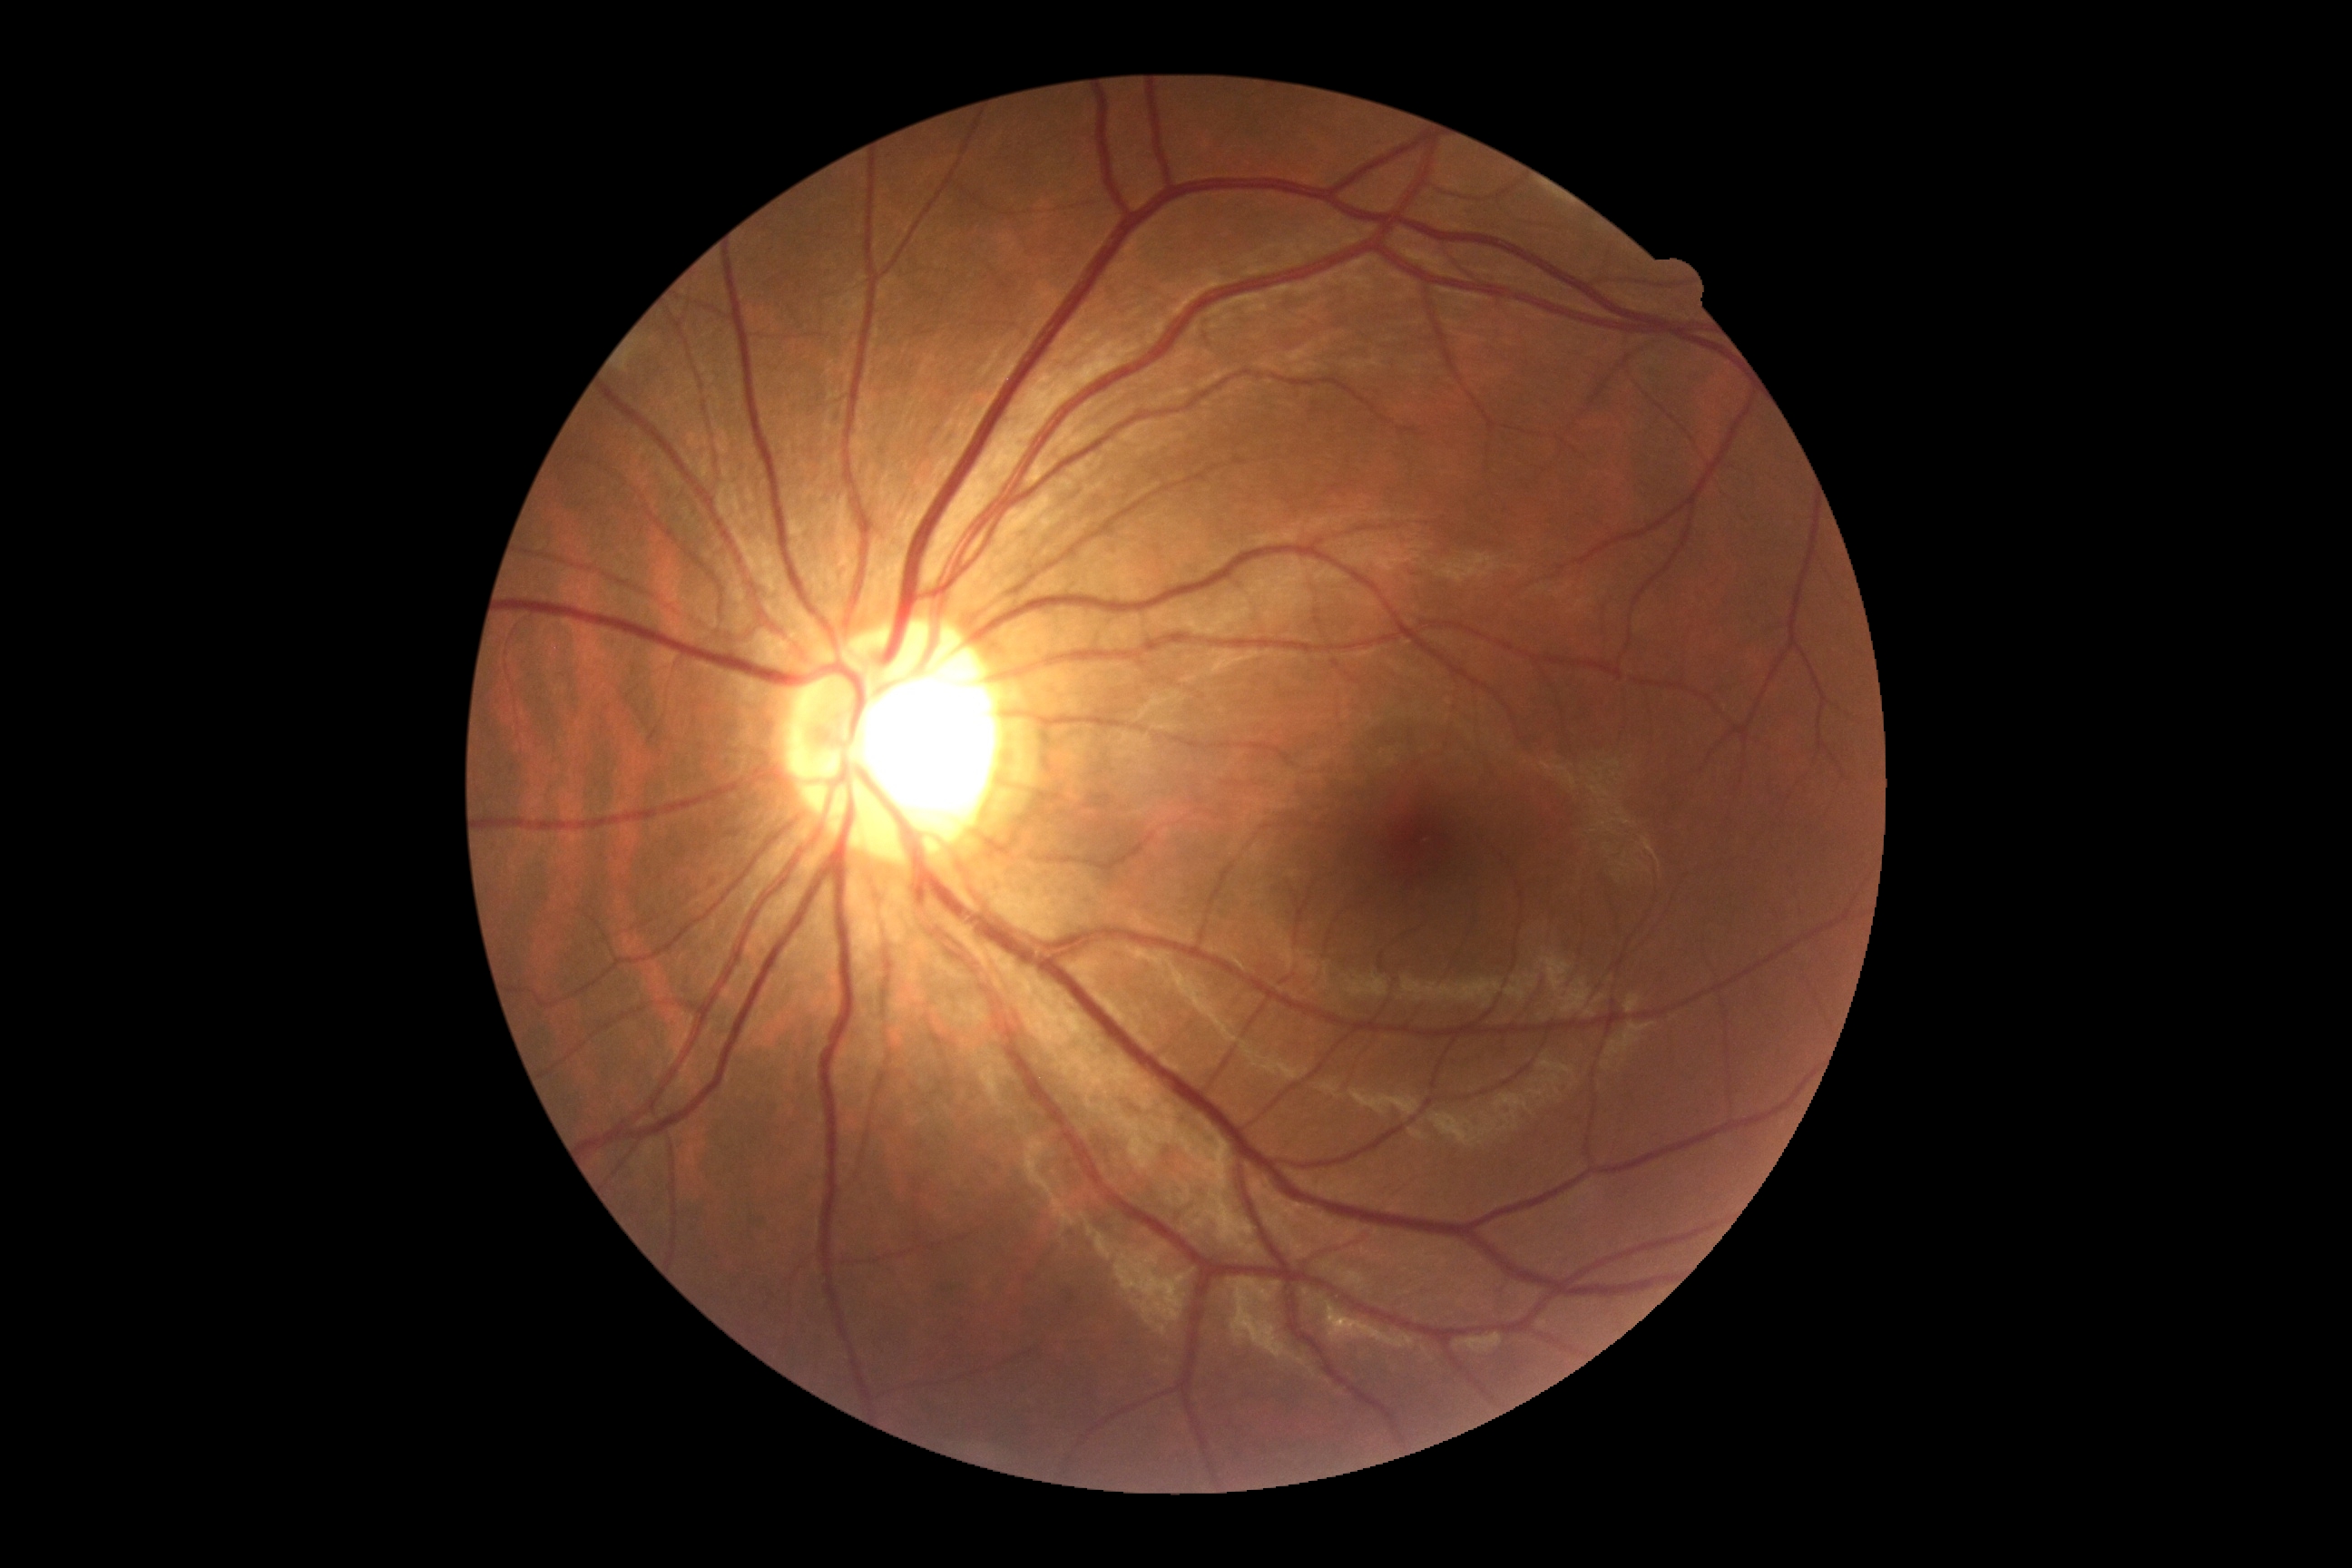
diabetic retinopathy severity: no apparent retinopathy (grade 0).